FOV: 45 degrees
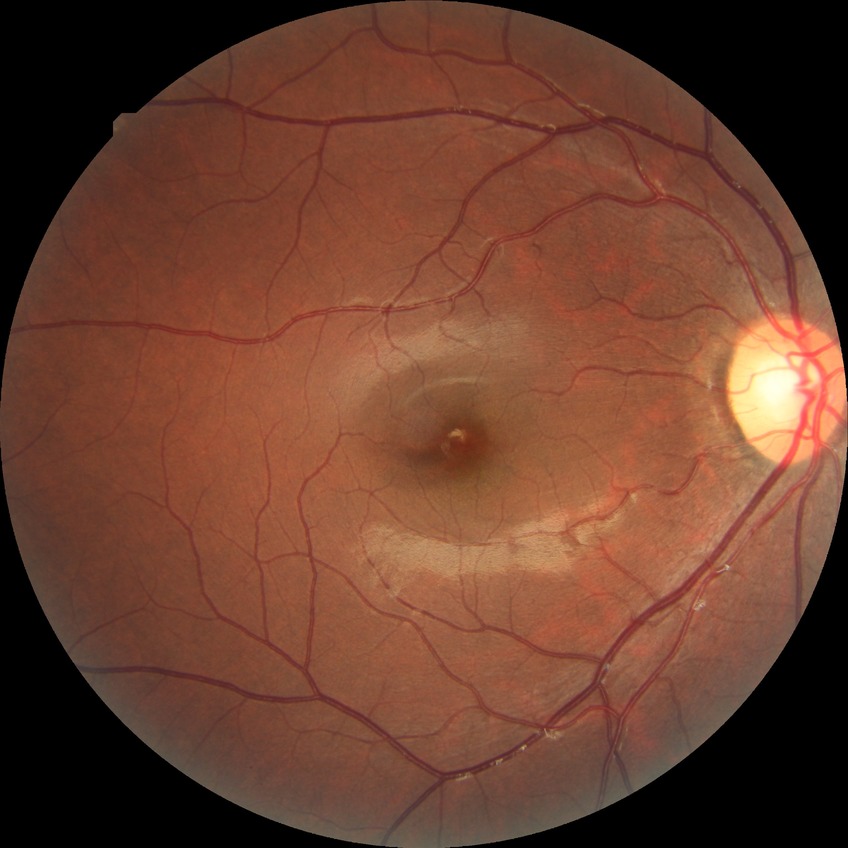 Findings:
• DR stage — NDR